FOV: 45 degrees. 1932 x 1910 pixels. CFP: 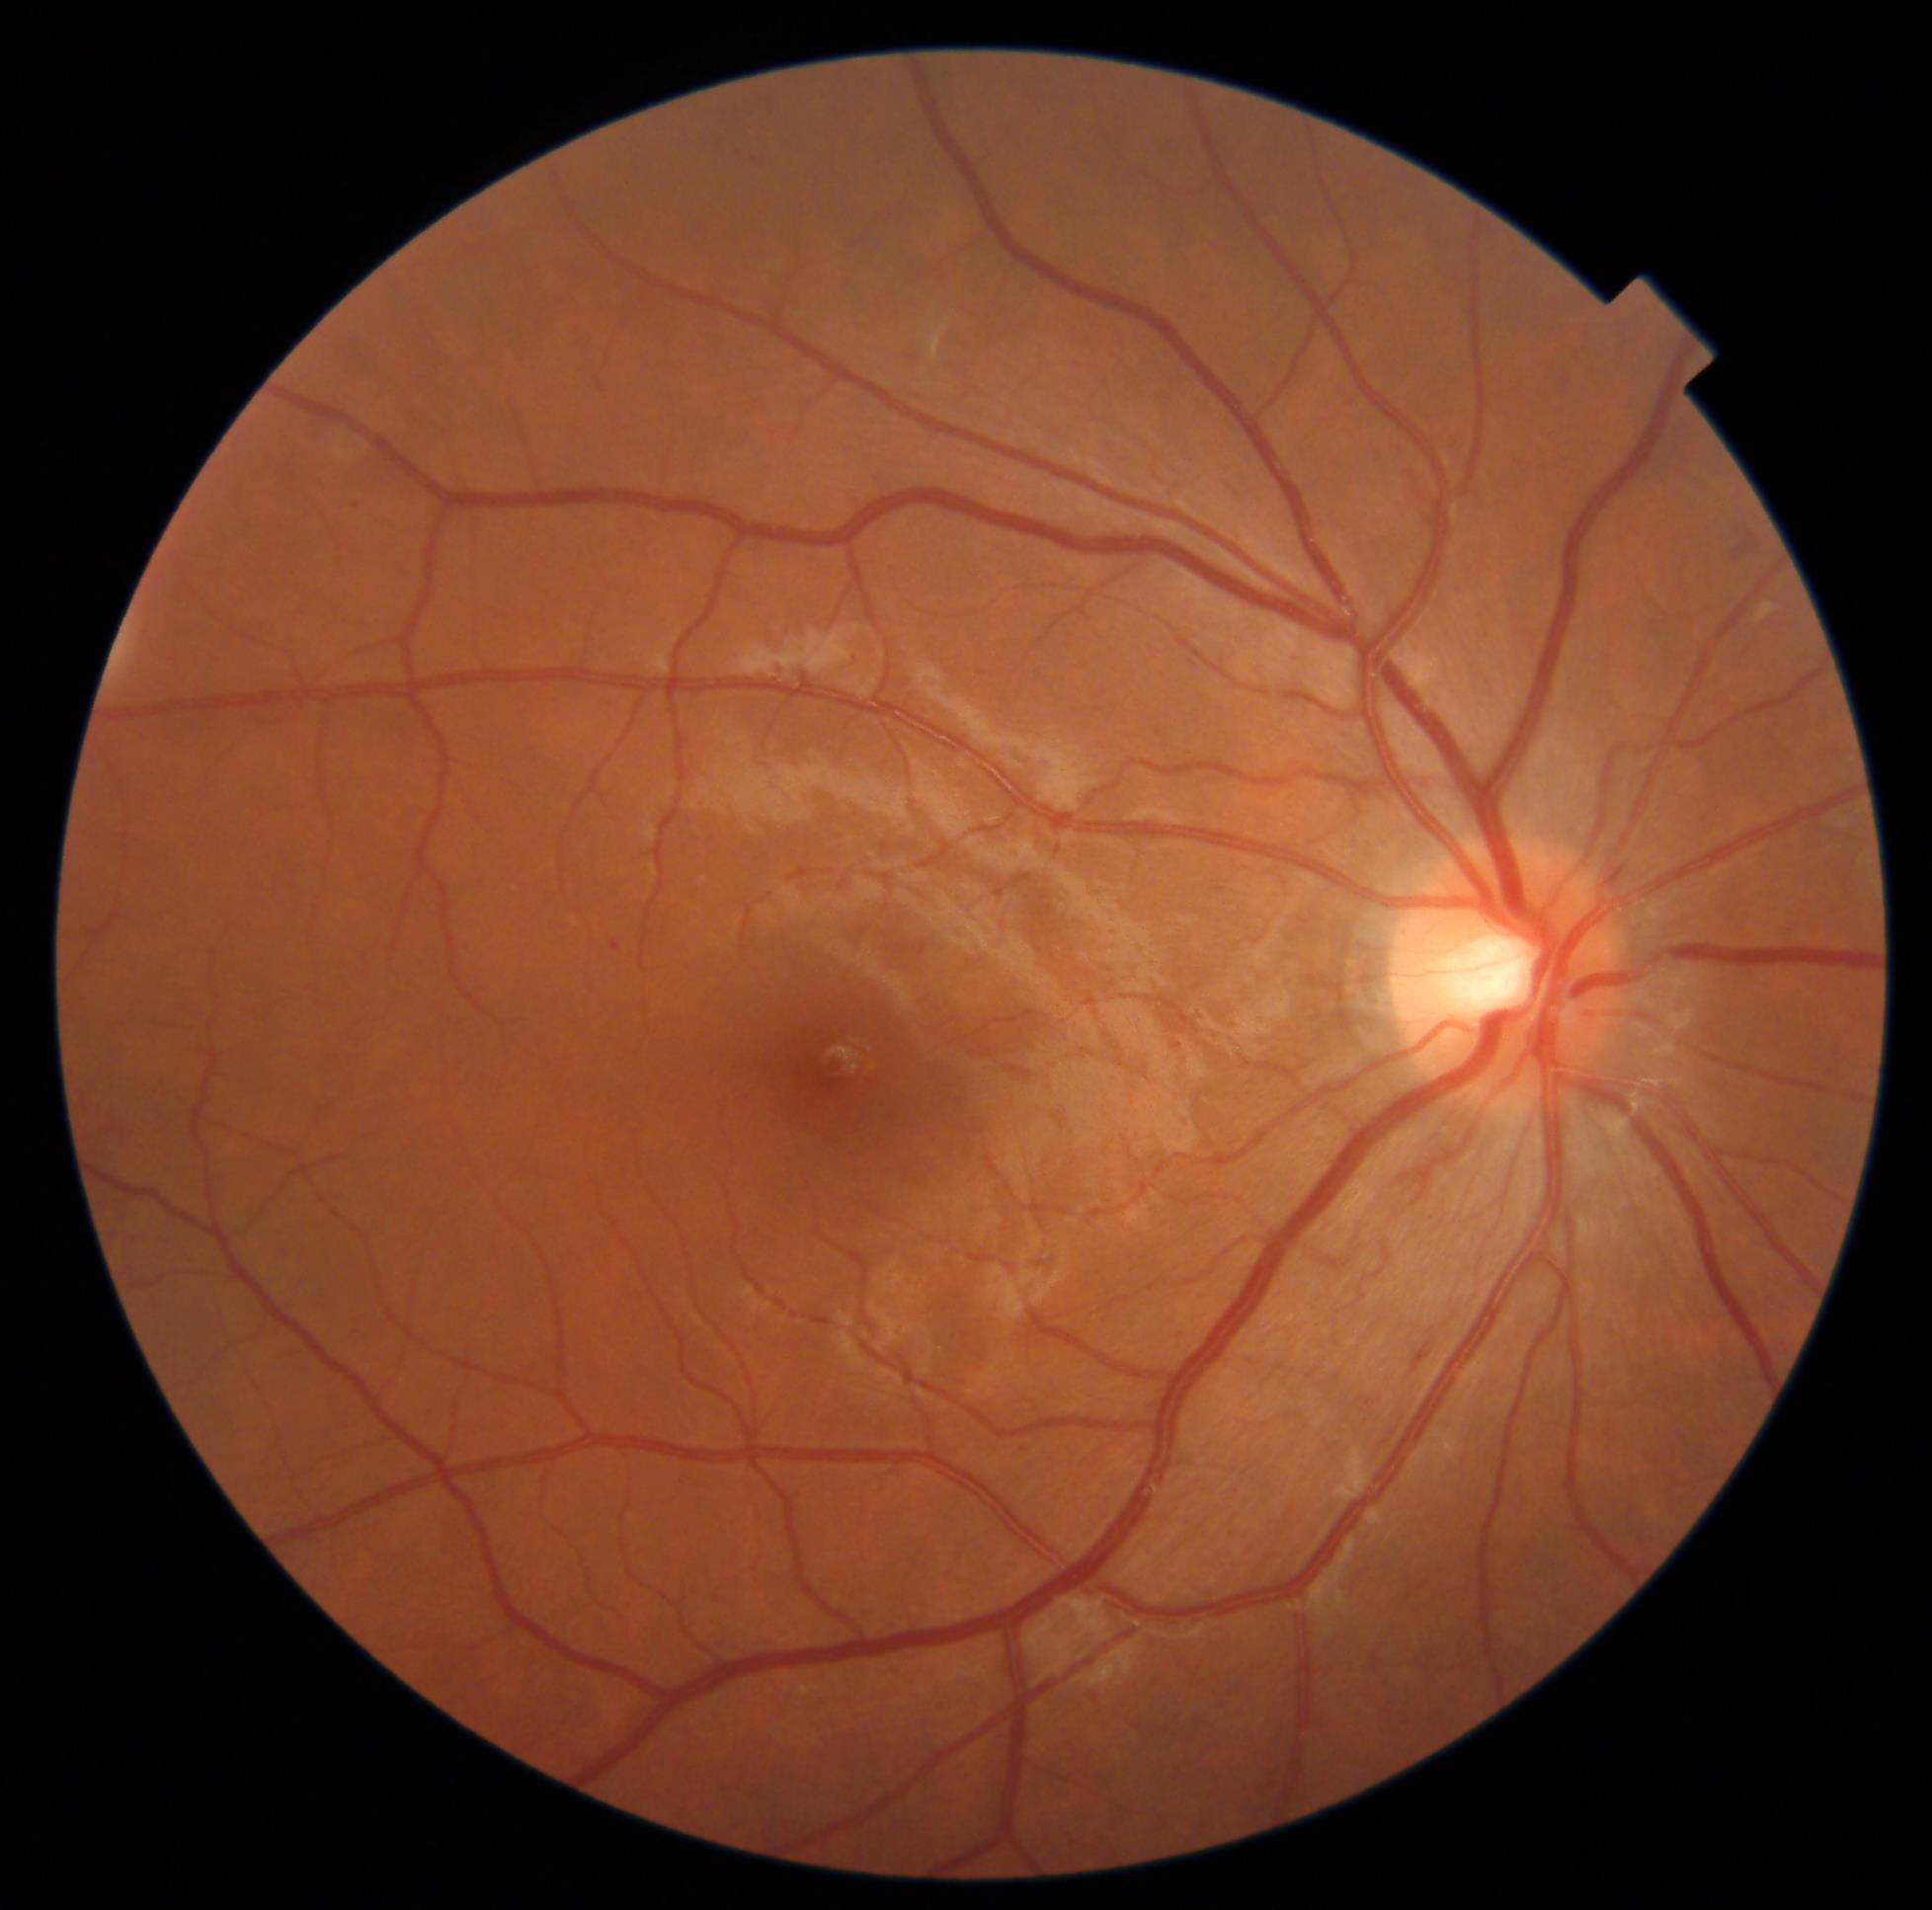 Diabetic retinopathy (DR) is moderate non-proliferative diabetic retinopathy (grade 2).